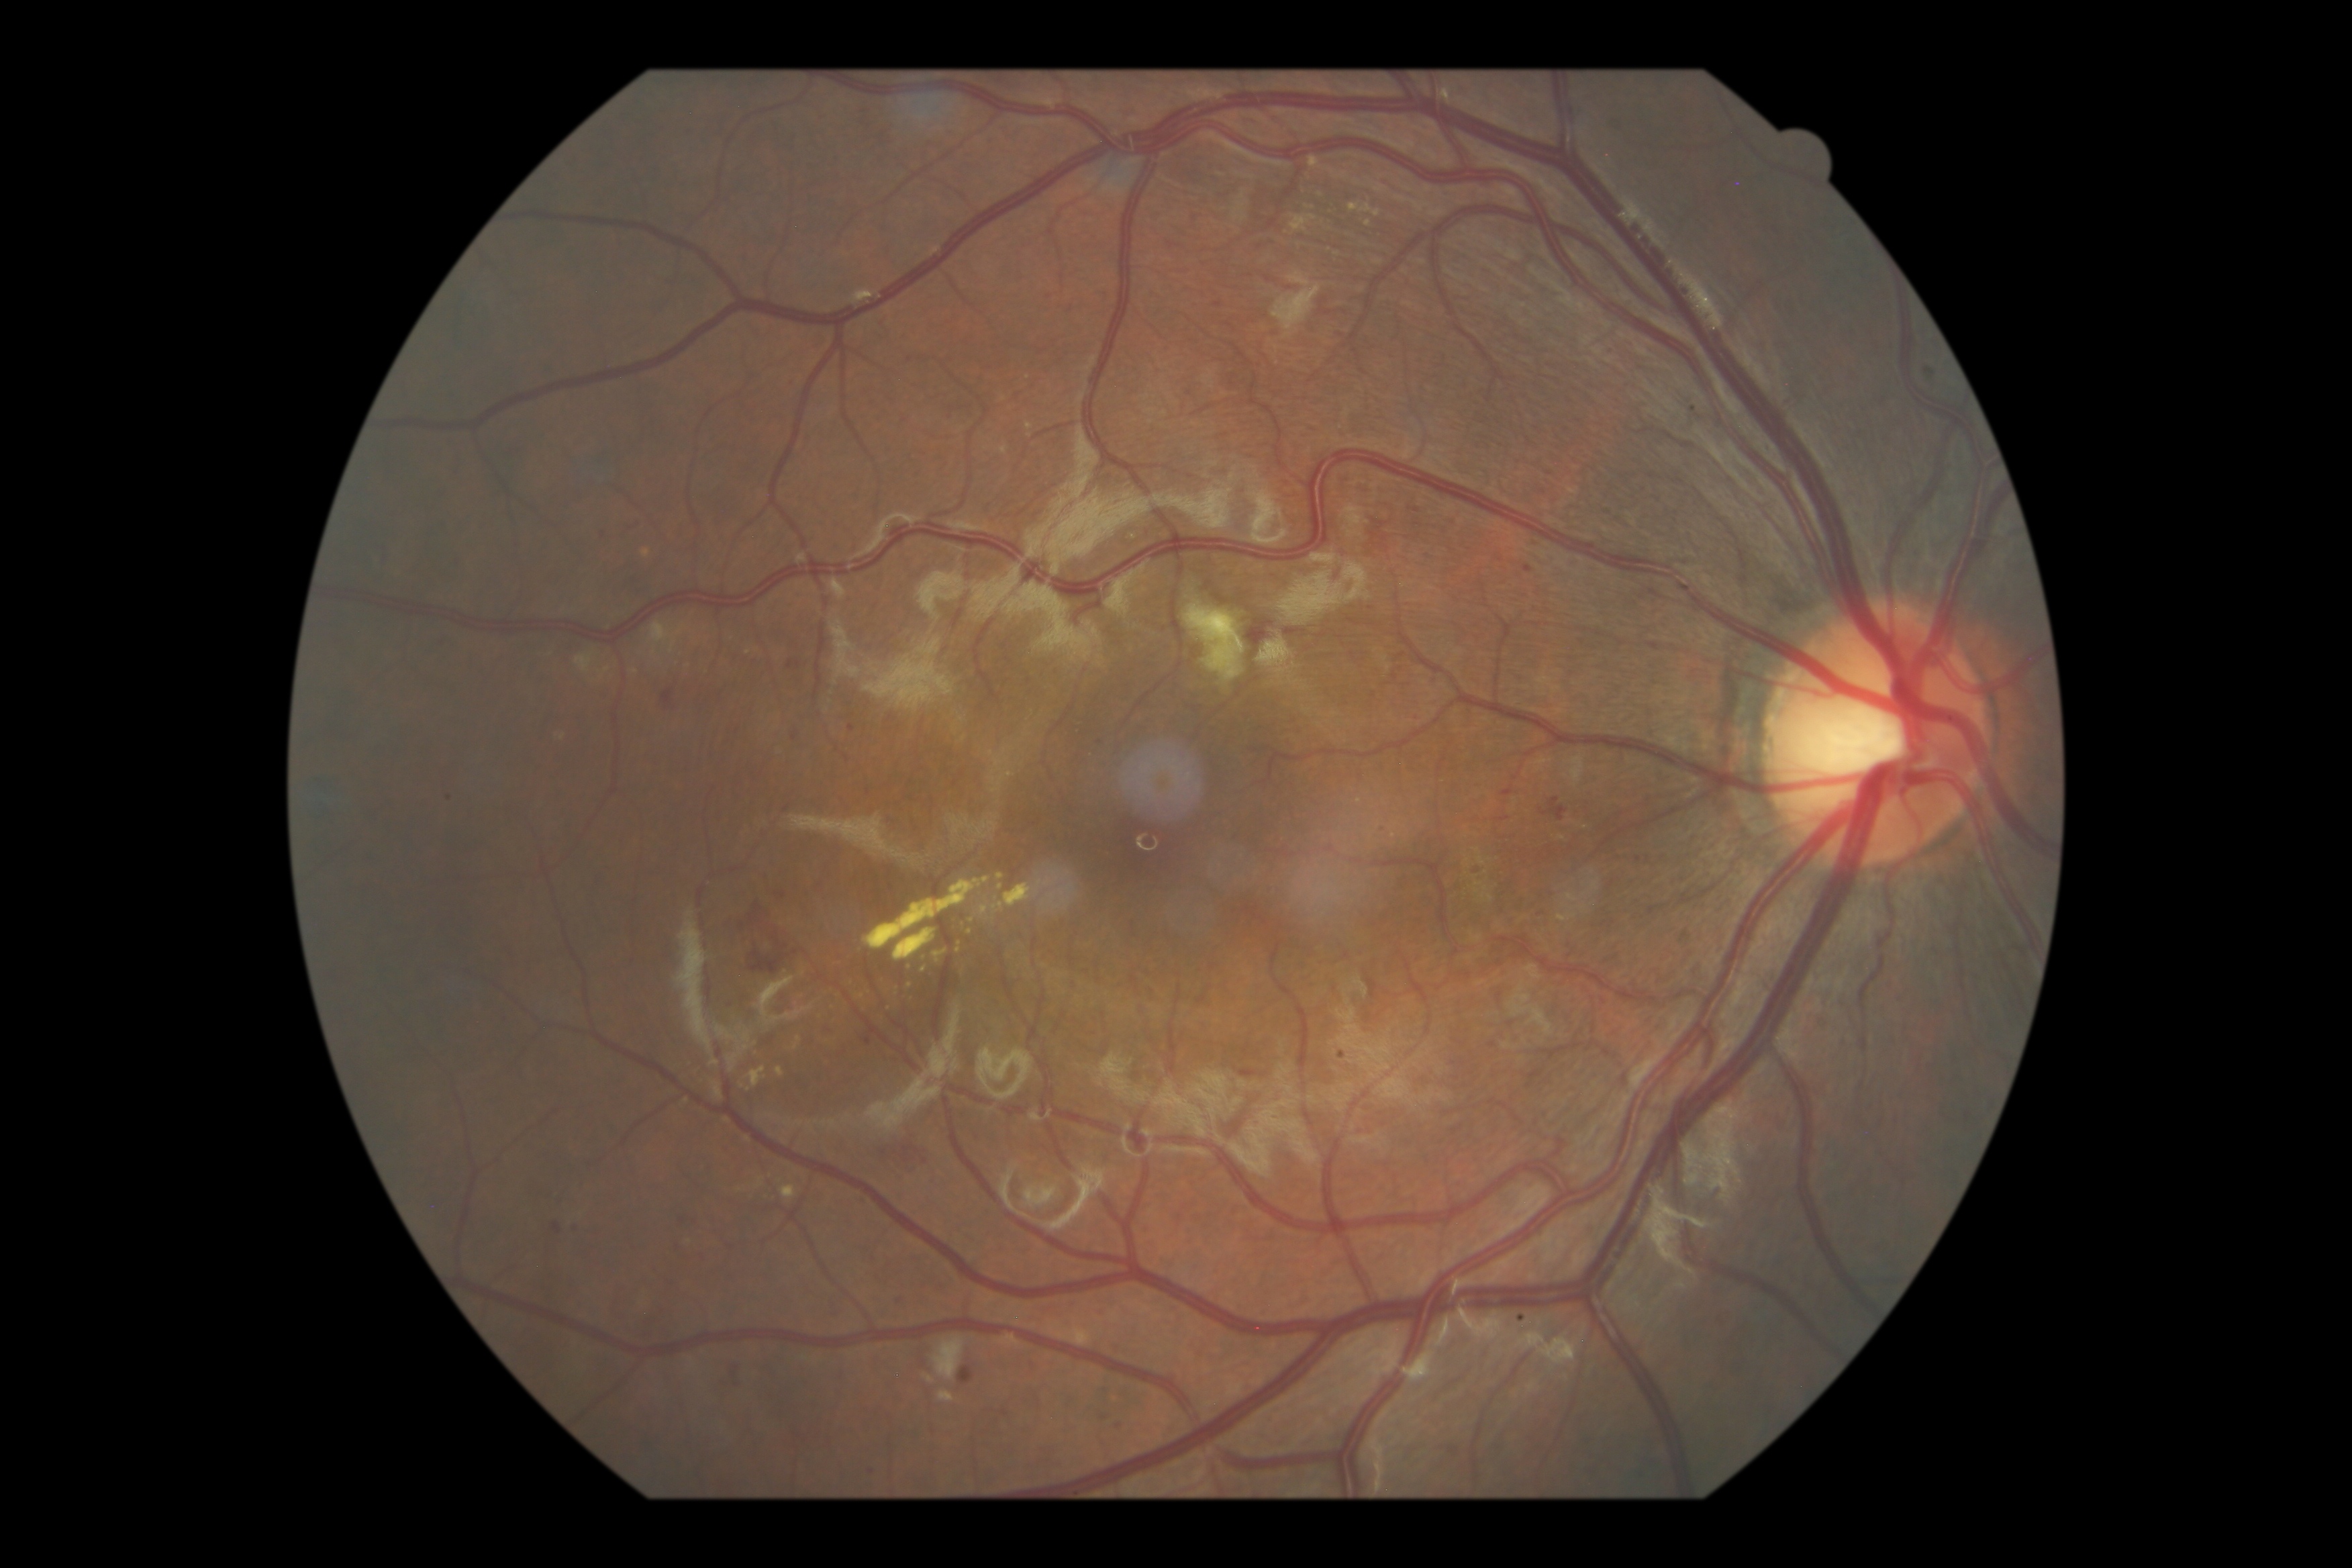
Retinopathy: 2 — more than just microaneurysms but less than severe NPDR.